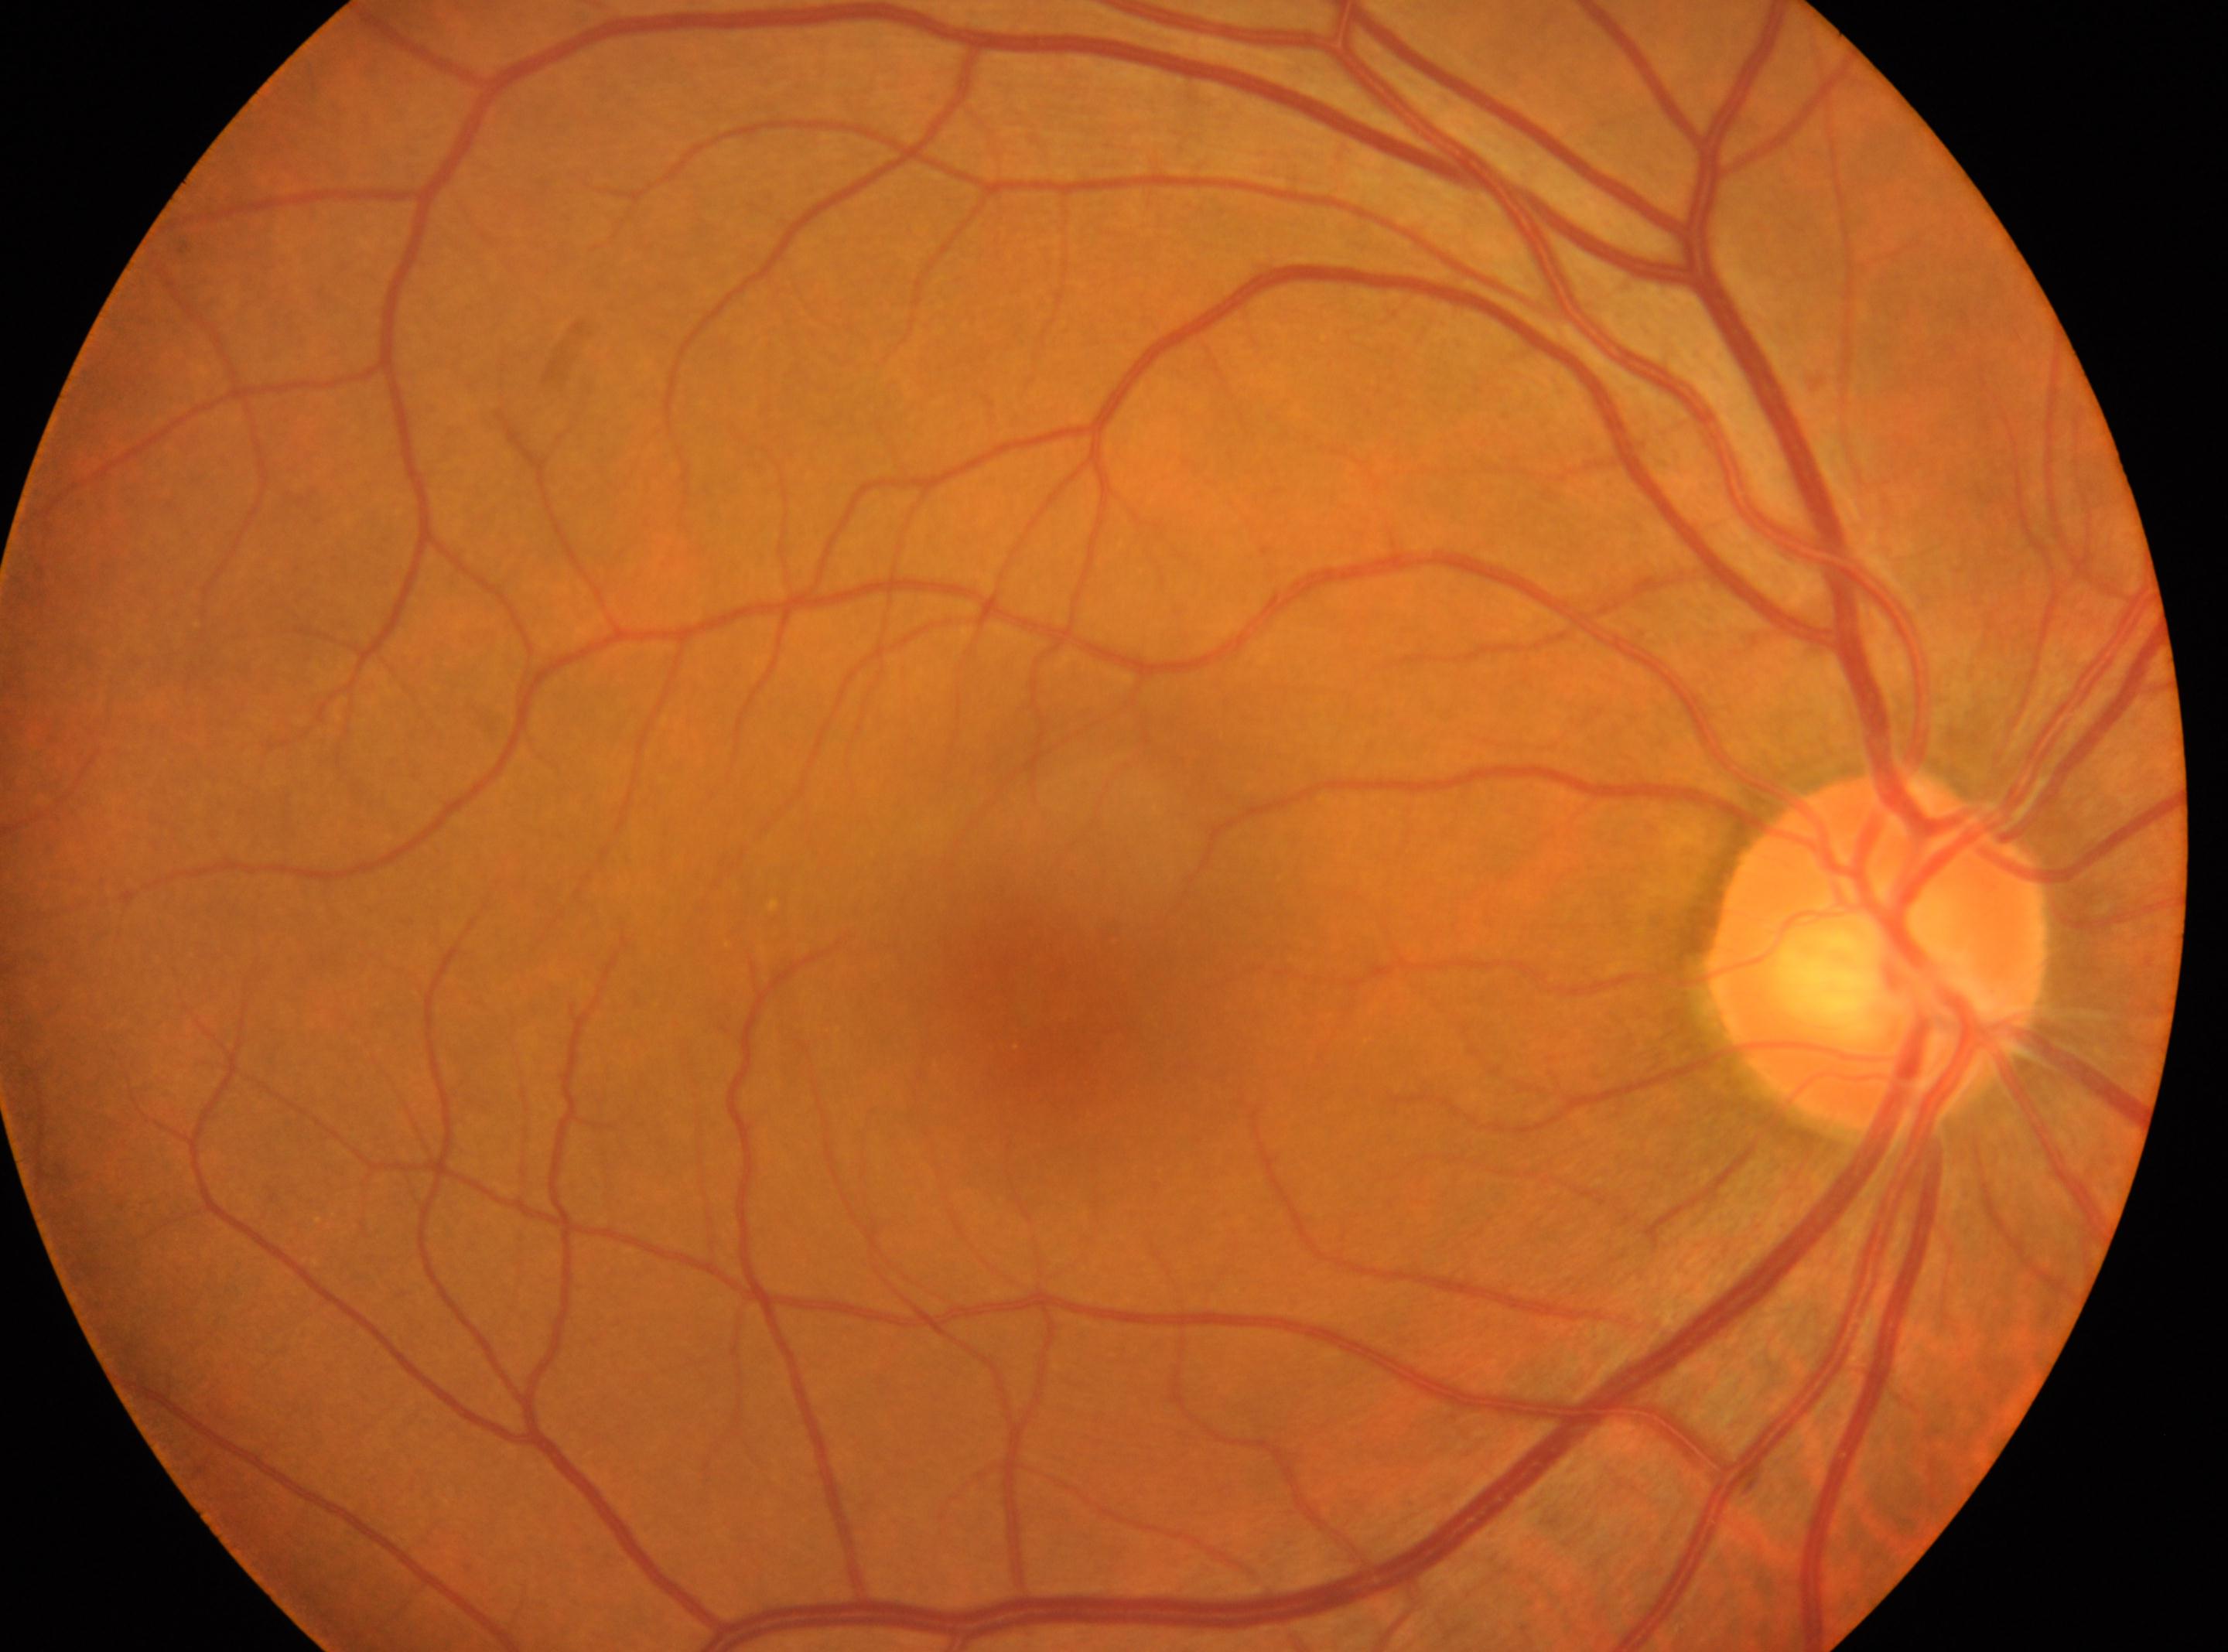
fovea center: [1040, 999], DR stage: no apparent retinopathy (grade 0), optic disc center: [1878, 947], eye: OD.